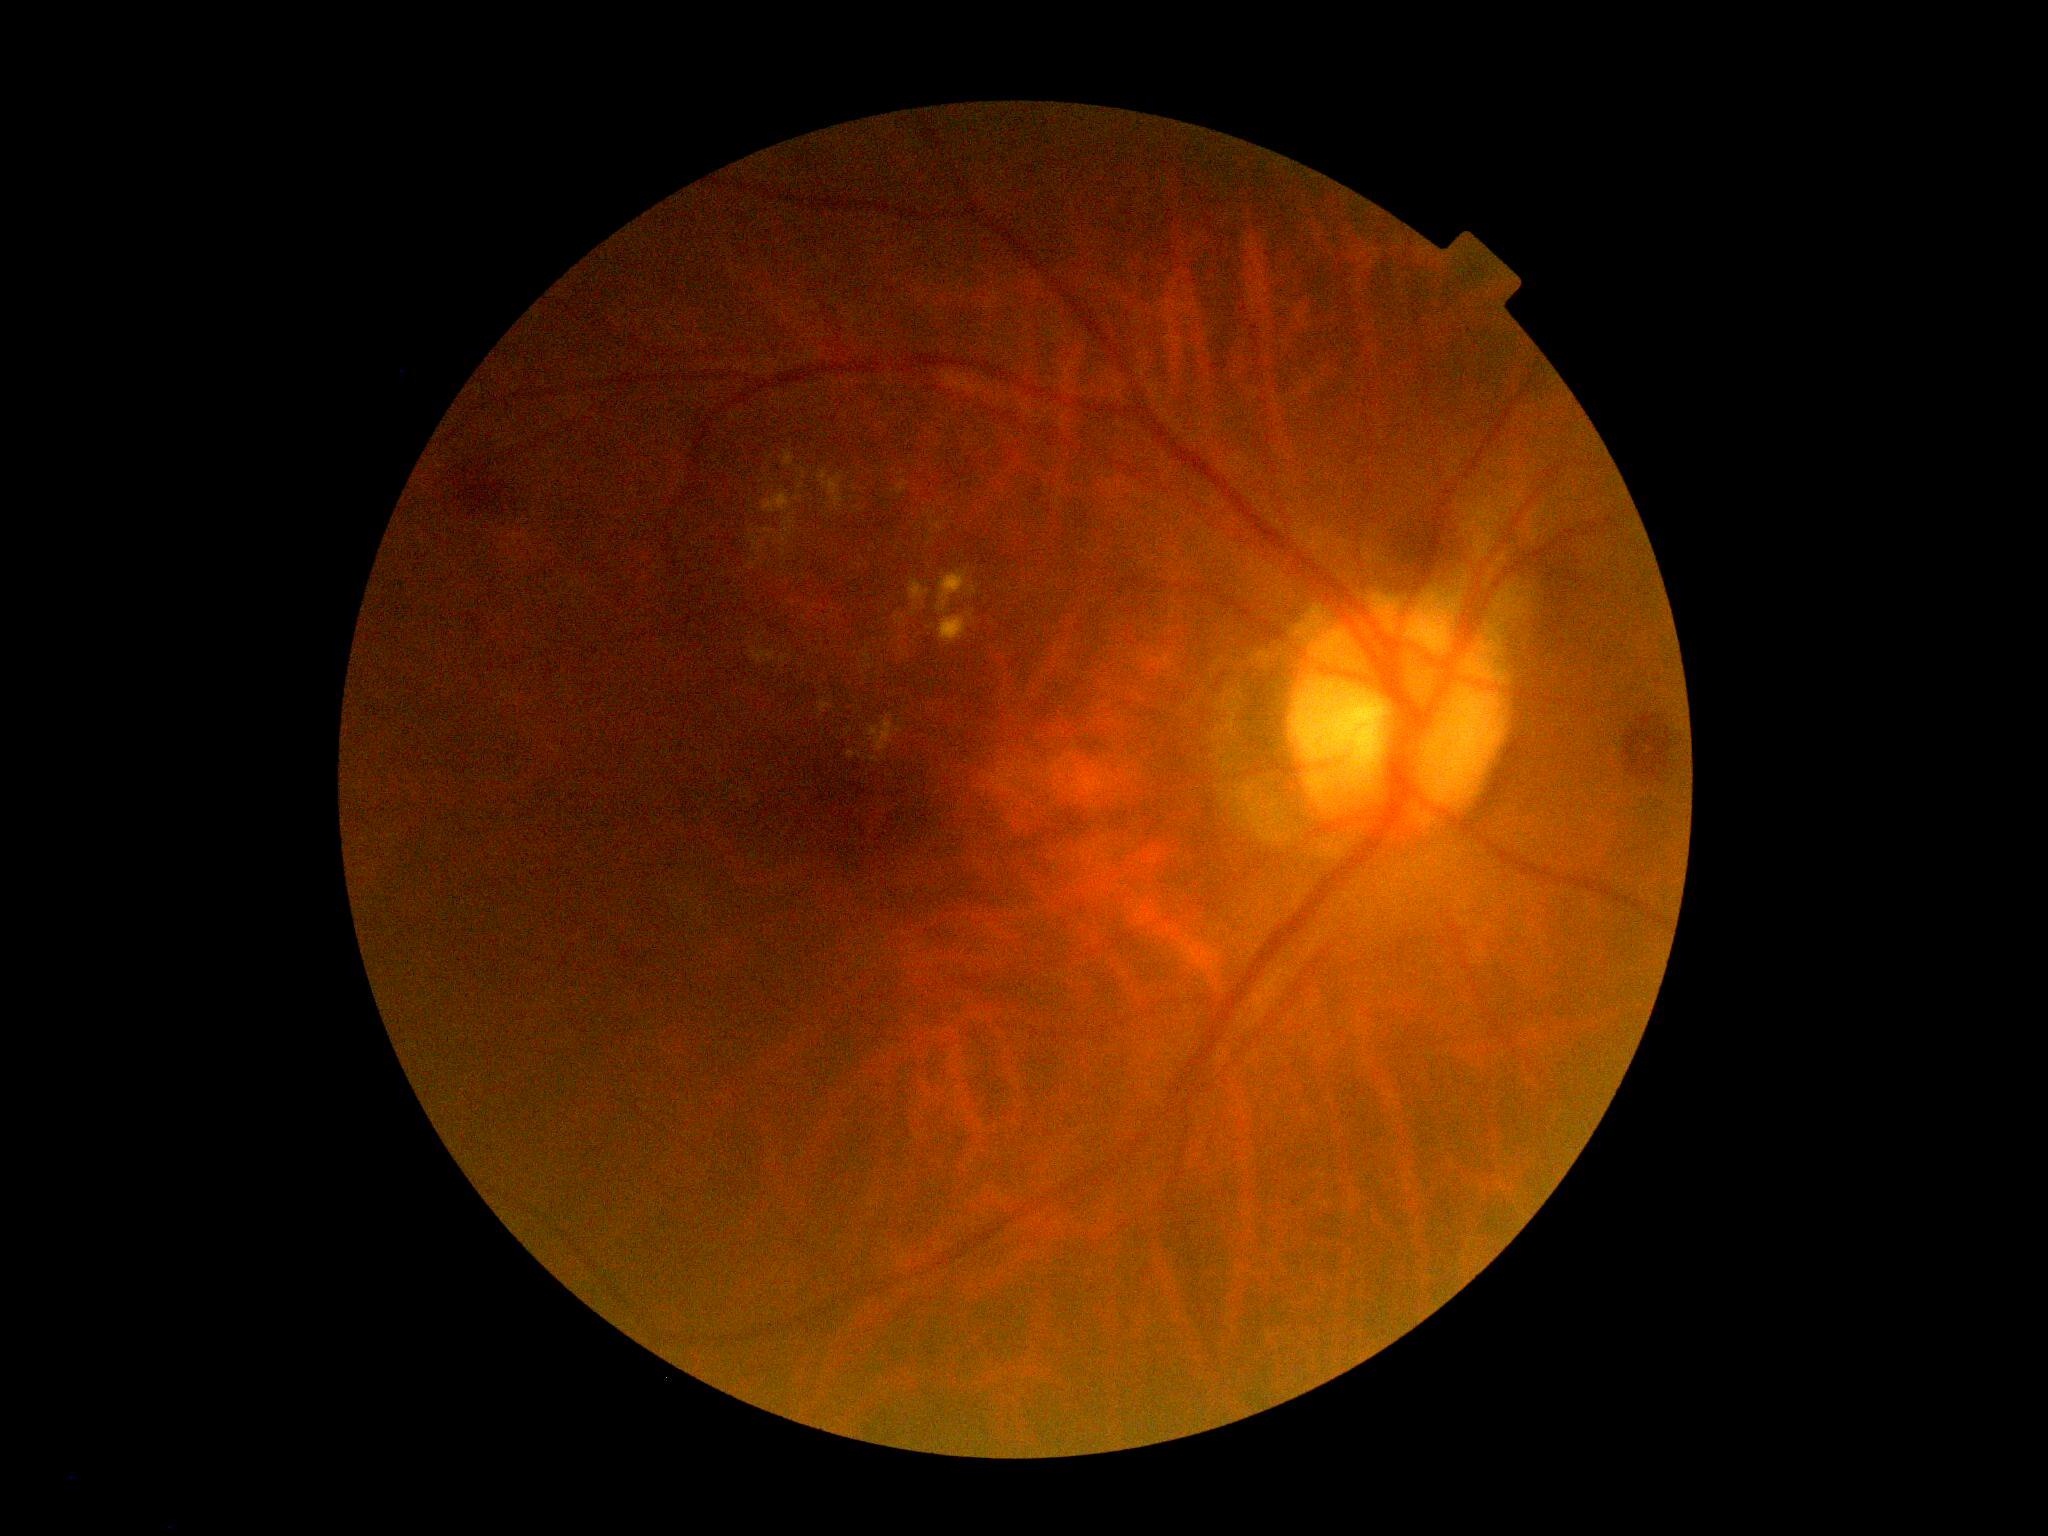 Diabetic retinopathy (DR): grade 2 (moderate NPDR).